Retinal fundus photograph.
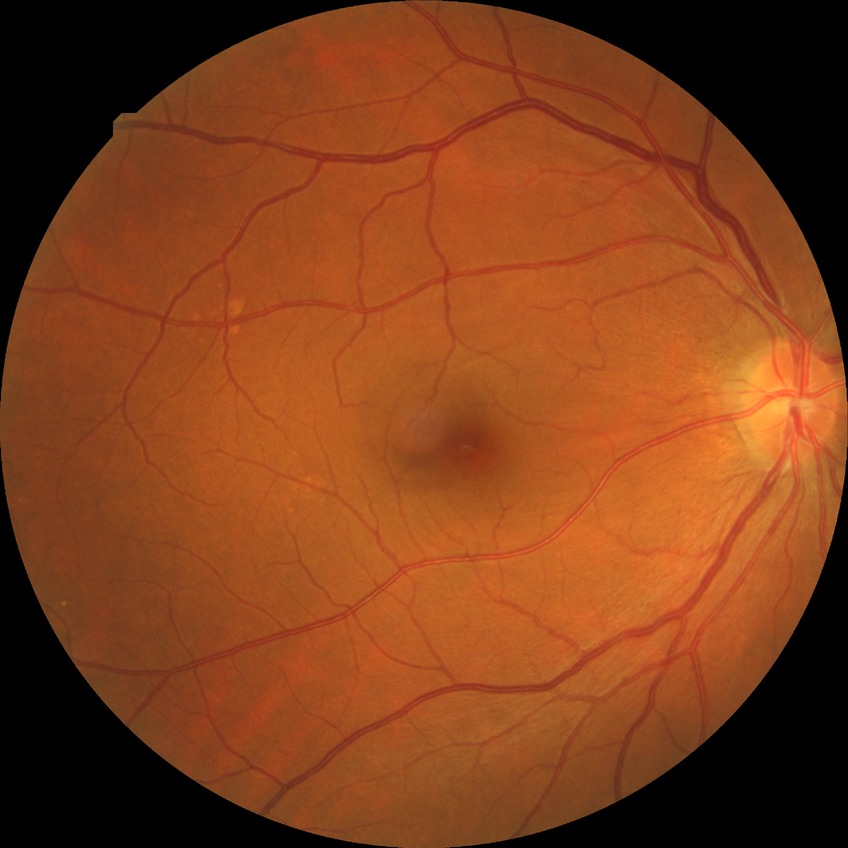

Assessment:
• DR stage: SDR